Acquired with a NIDEK AFC-230; FOV: 45 degrees; image size 848x848; nonmydriatic fundus photograph
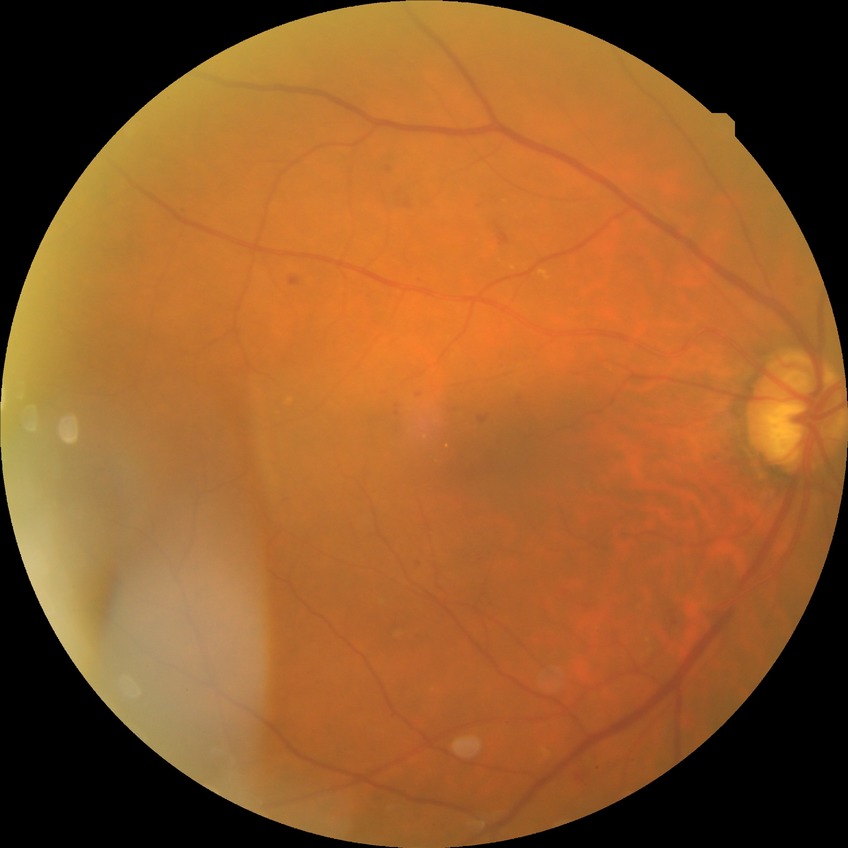

DR grade is SDR.